Color fundus photograph · 2212x1659px · 45° FOV: 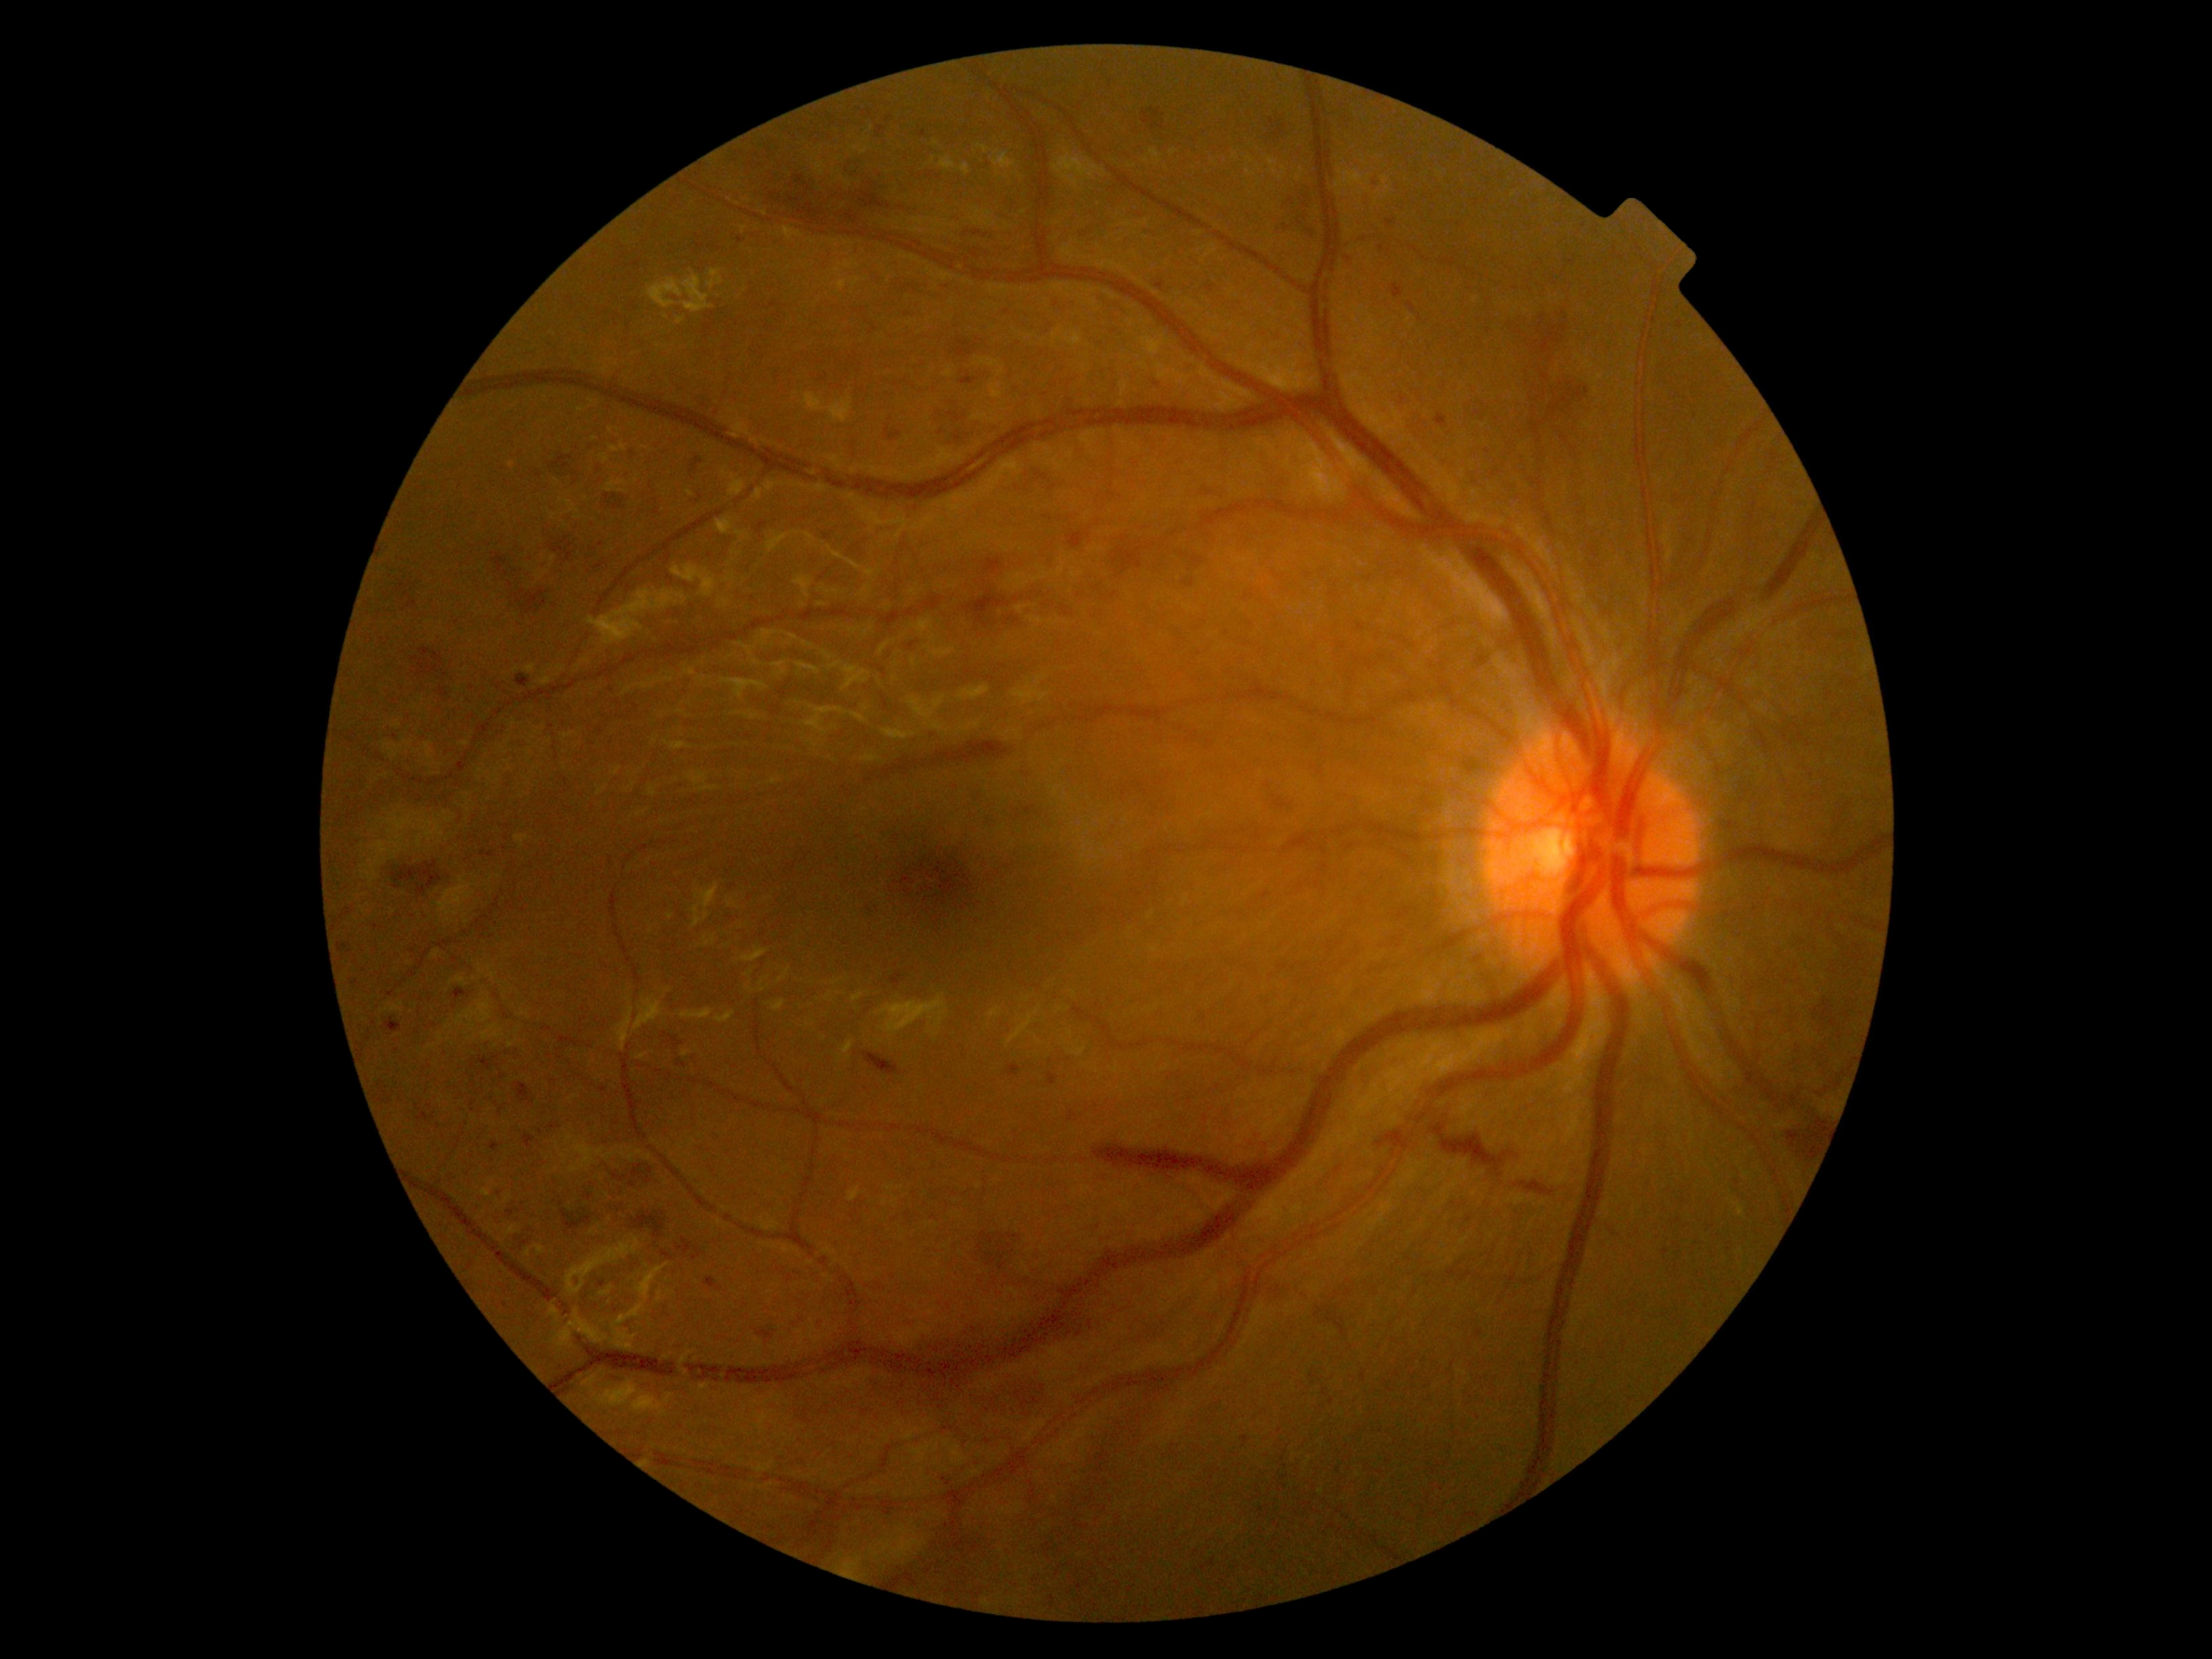 DR severity is severe non-proliferative diabetic retinopathy (grade 3); non-proliferative diabetic retinopathy
Selected lesions:
* HEs (continued): region(764, 173, 960, 235); region(876, 127, 884, 138); region(971, 1230, 1028, 1287); region(704, 1279, 722, 1291); region(1375, 1131, 1410, 1151); region(502, 1204, 523, 1225); region(480, 851, 495, 859); region(1203, 284, 1216, 296); region(1155, 280, 1169, 293); region(857, 905, 879, 920); region(340, 943, 350, 952); region(1363, 173, 1387, 215)
* Additional small HEs near (541, 1132); (751, 164); (376, 927); (823, 379); (923, 134); (602, 545); (563, 1308)